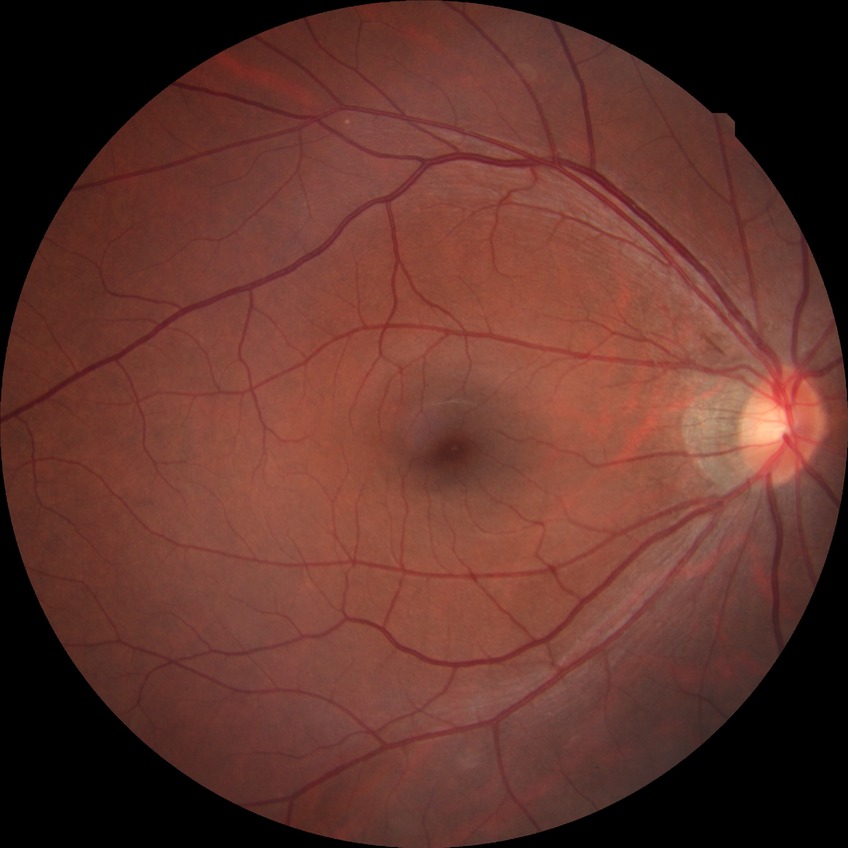 Diabetic retinopathy (DR): no diabetic retinopathy (NDR).